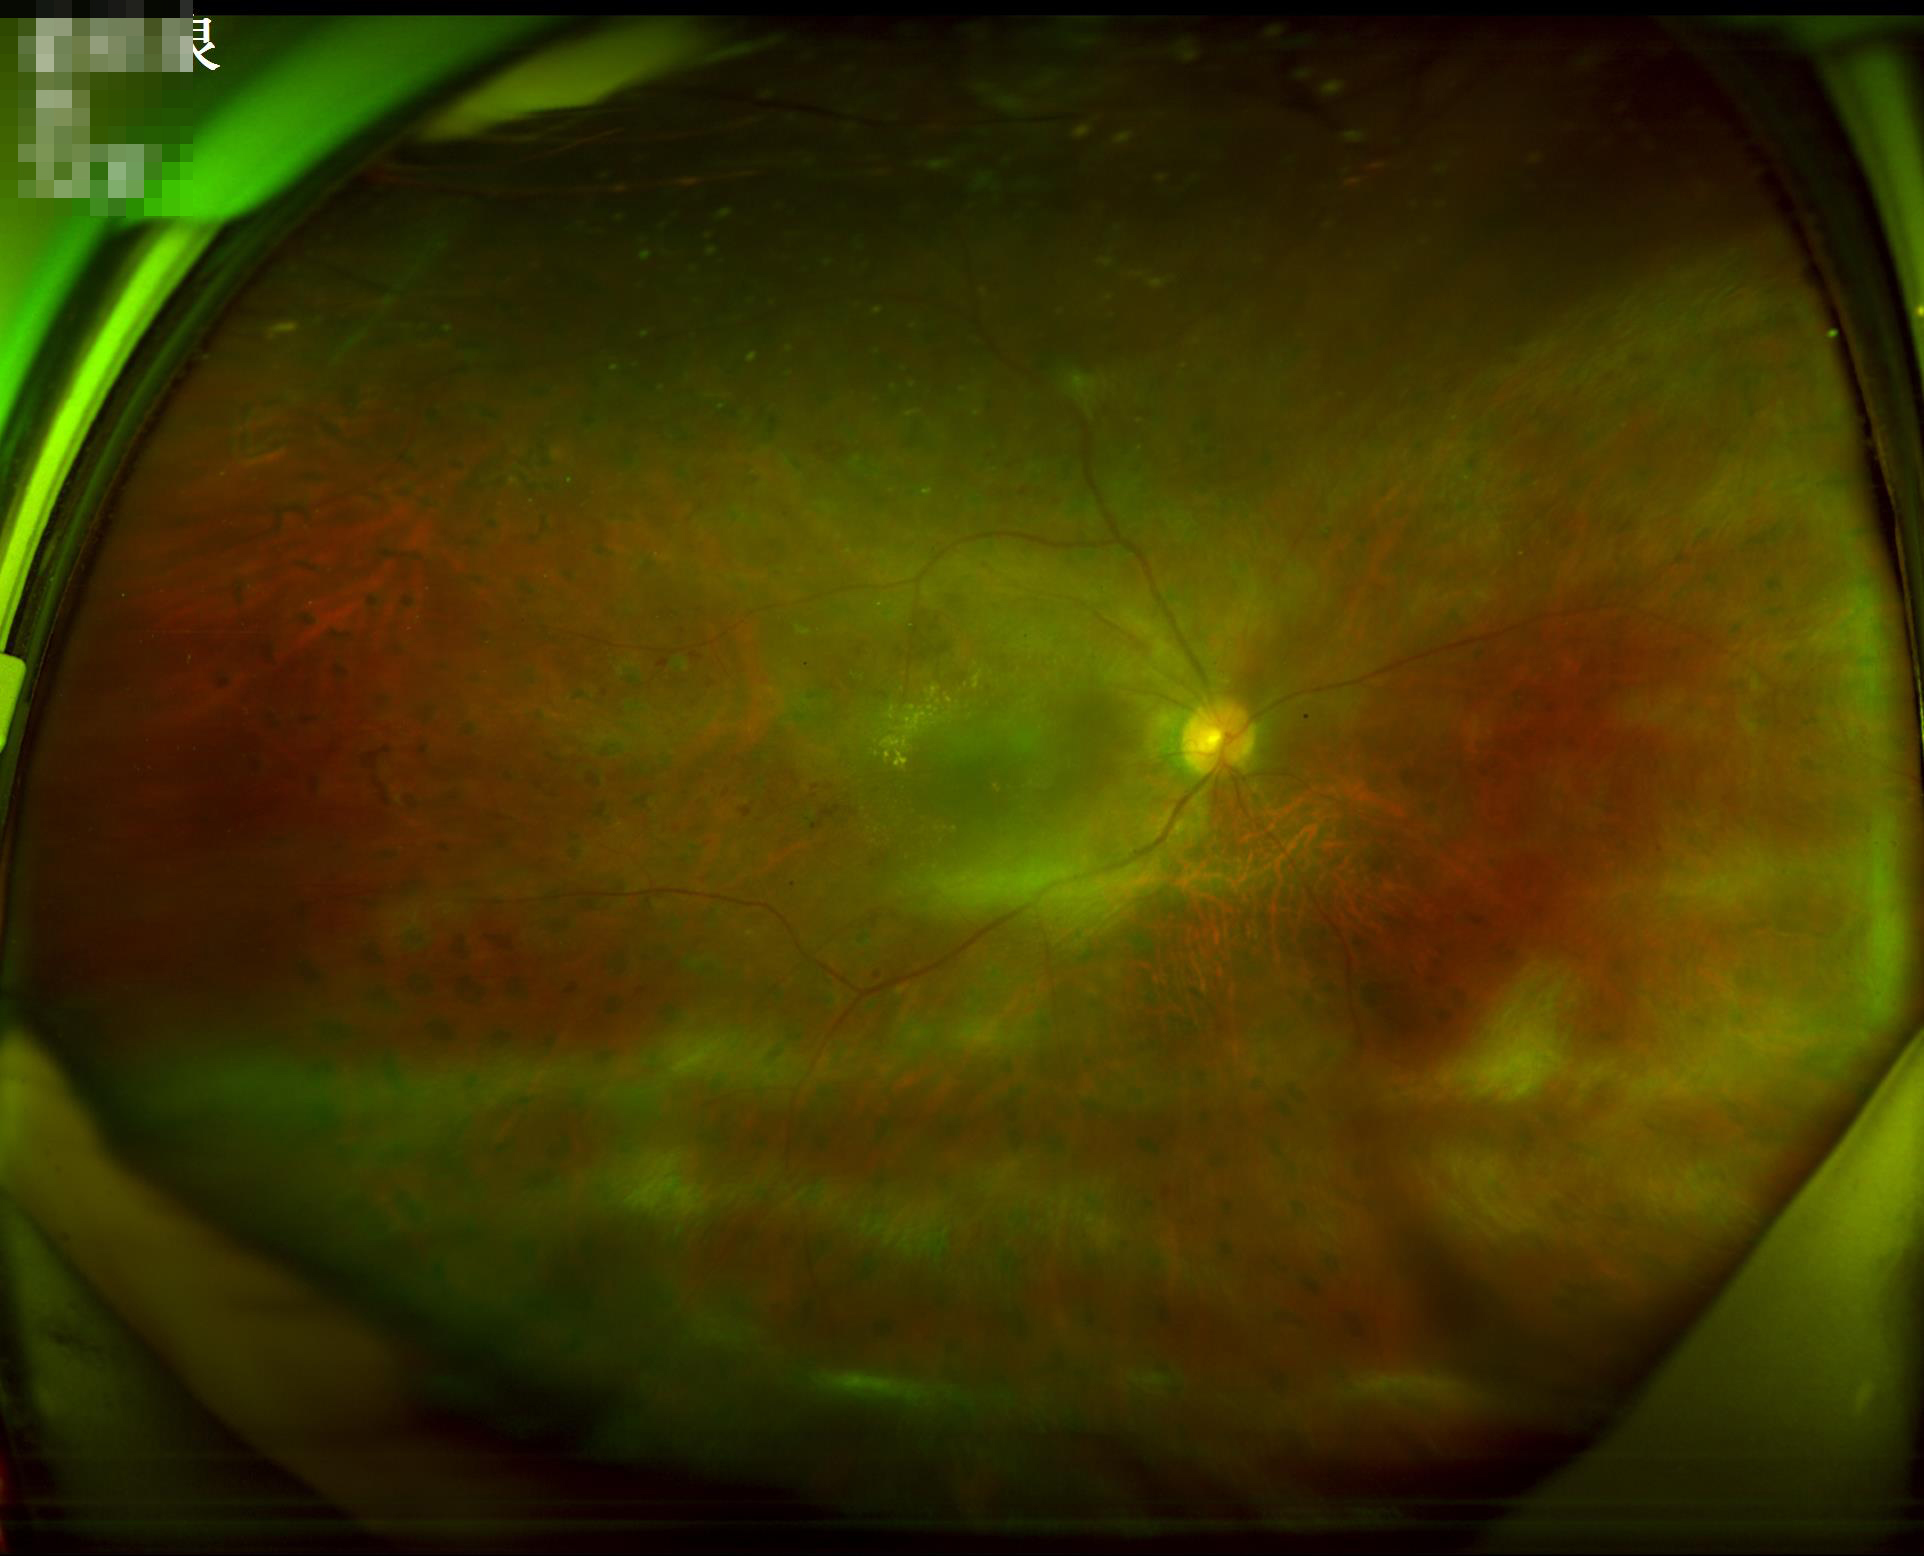
Quality assessment: overall: poor | clarity: blurry | illumination/color: suboptimal | contrast: good.